45° FOV:
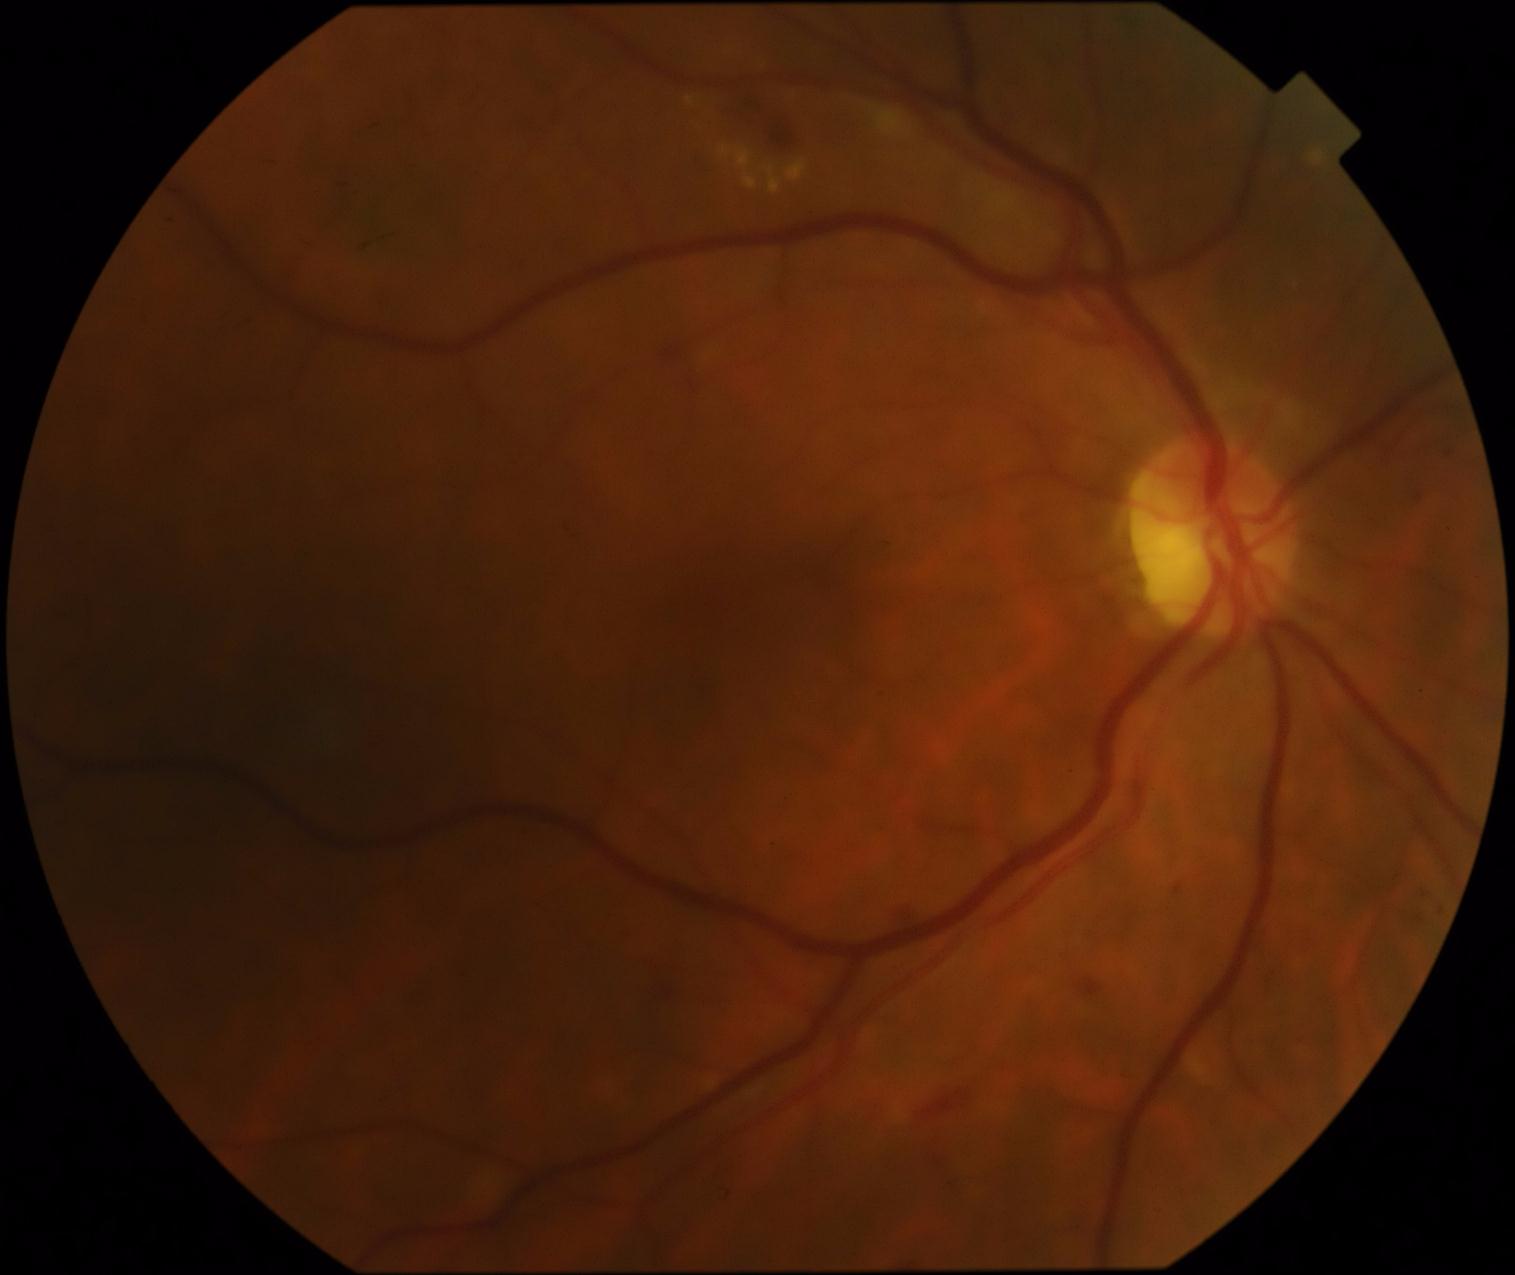 Retinopathy: 2.